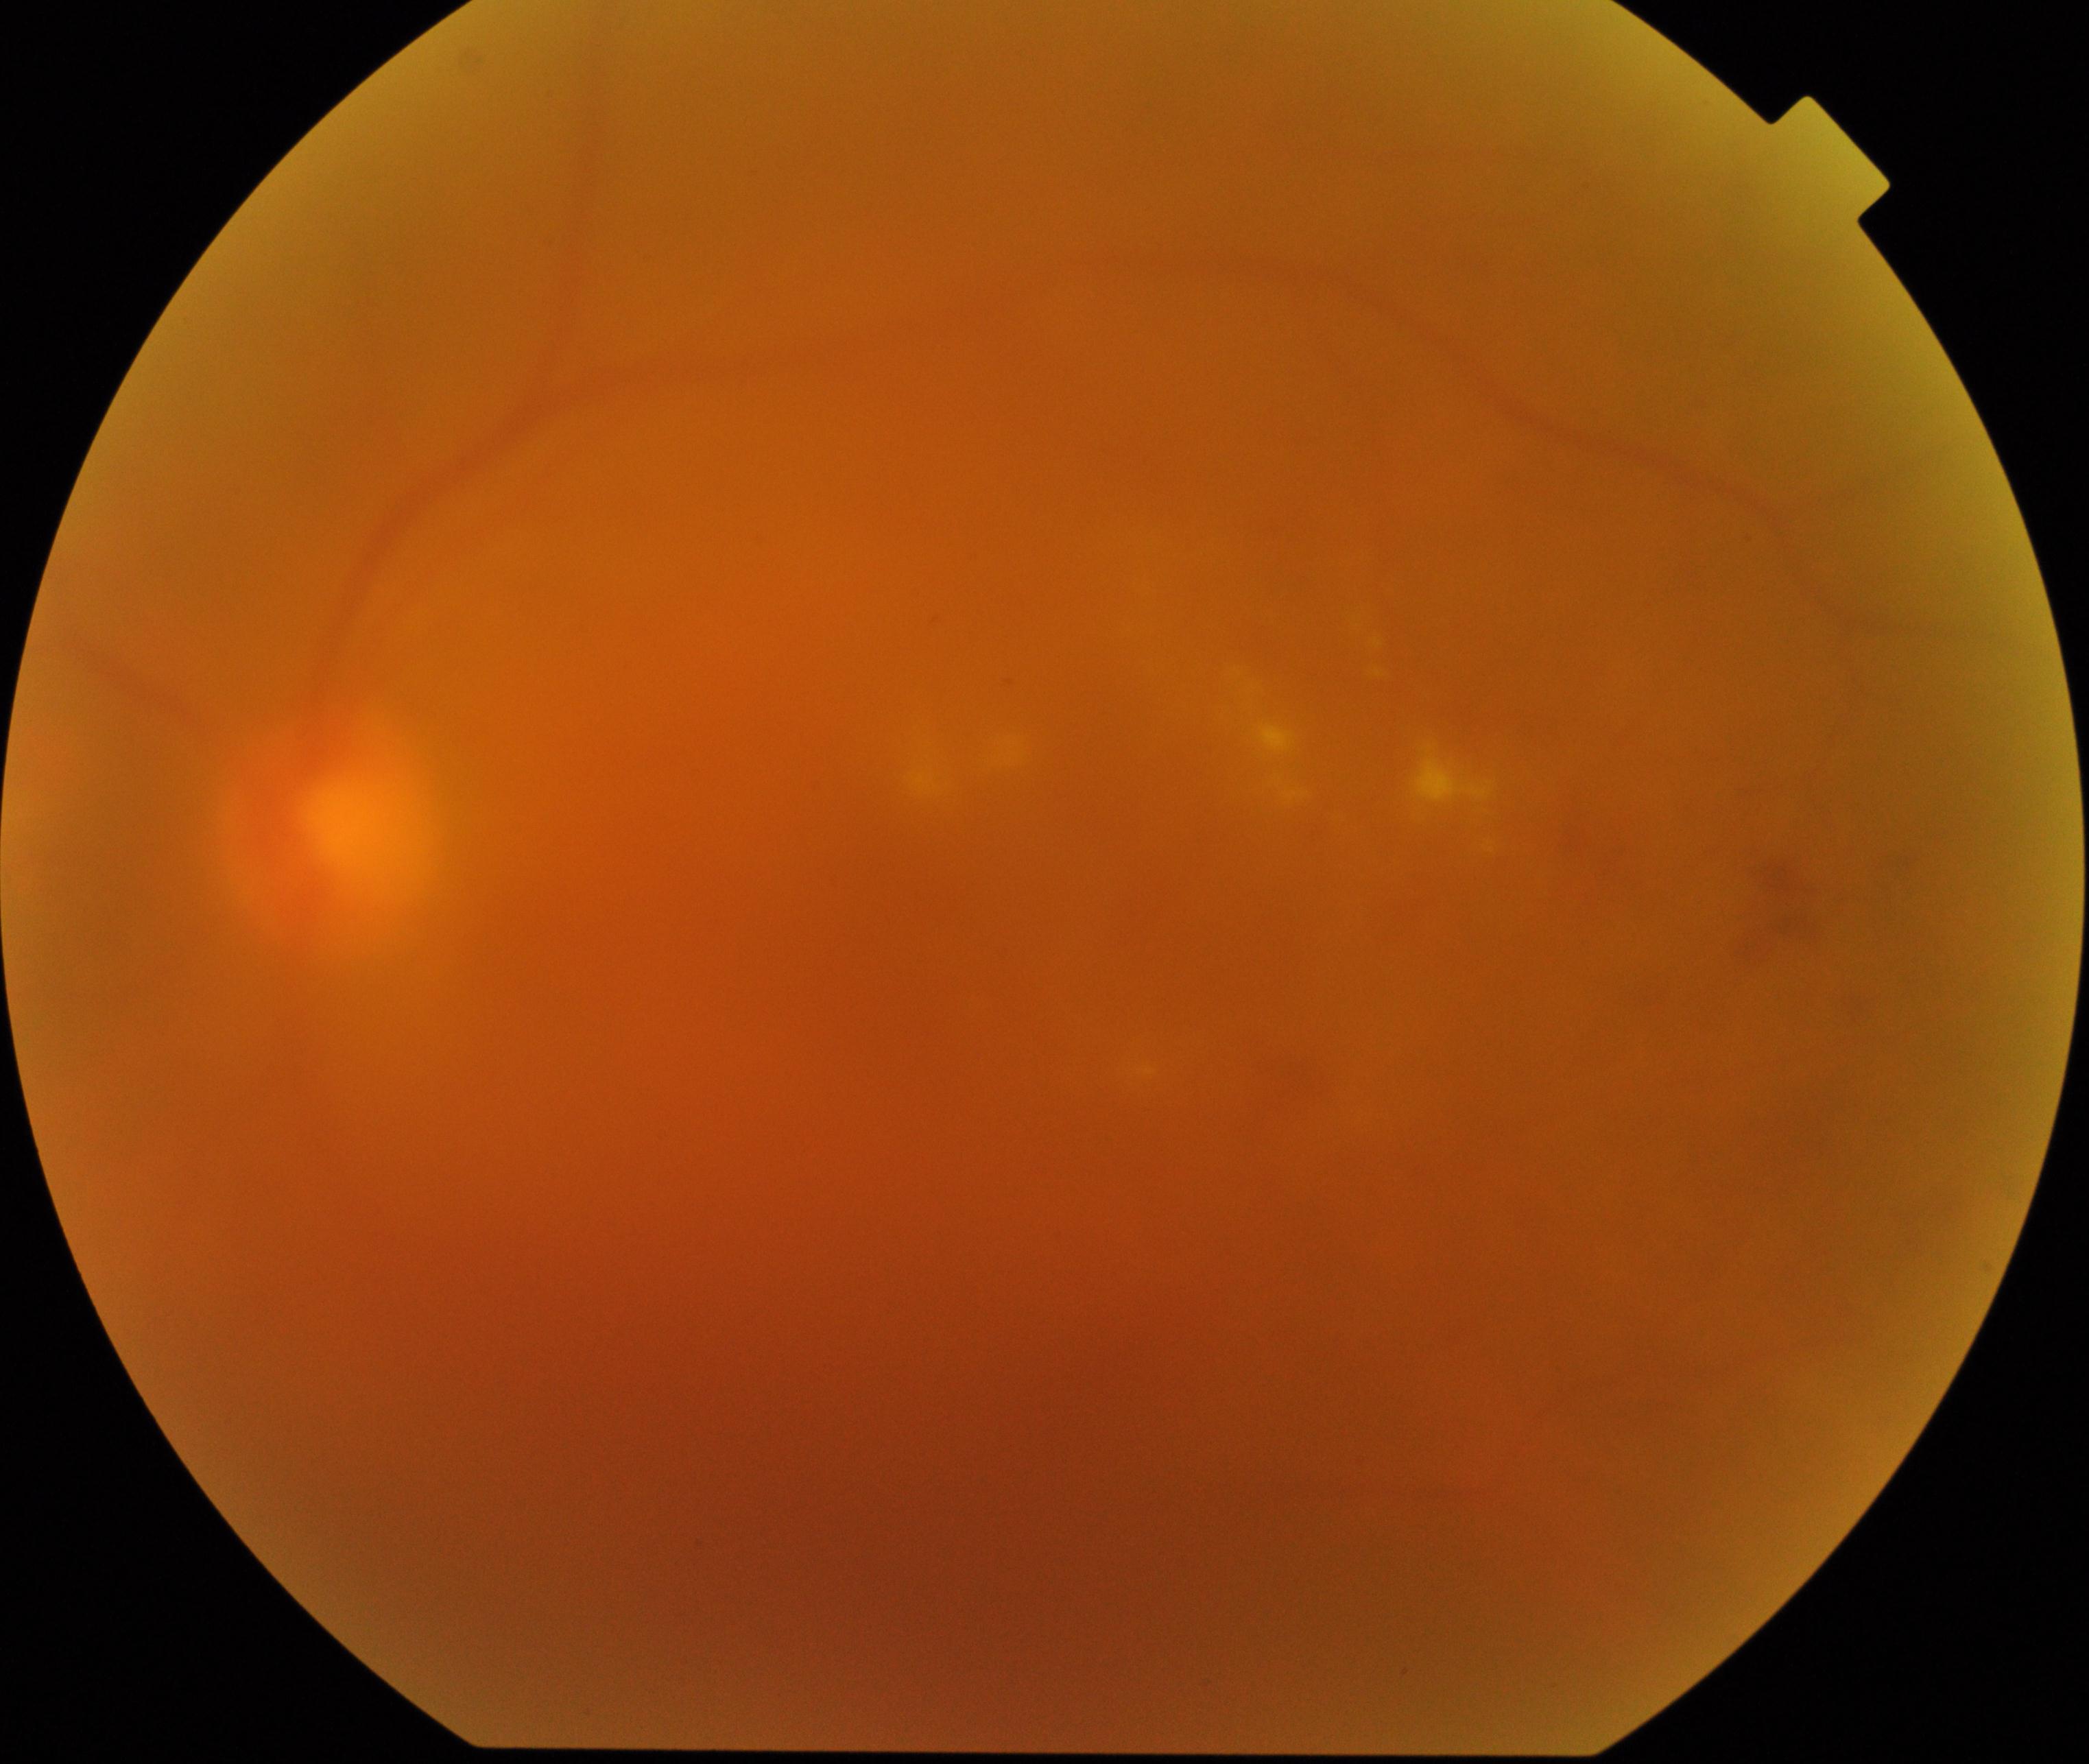
Blurred fundus image with substantial obscuration of retinal landmarks. Proliferative diabetic retinopathy is suspected.